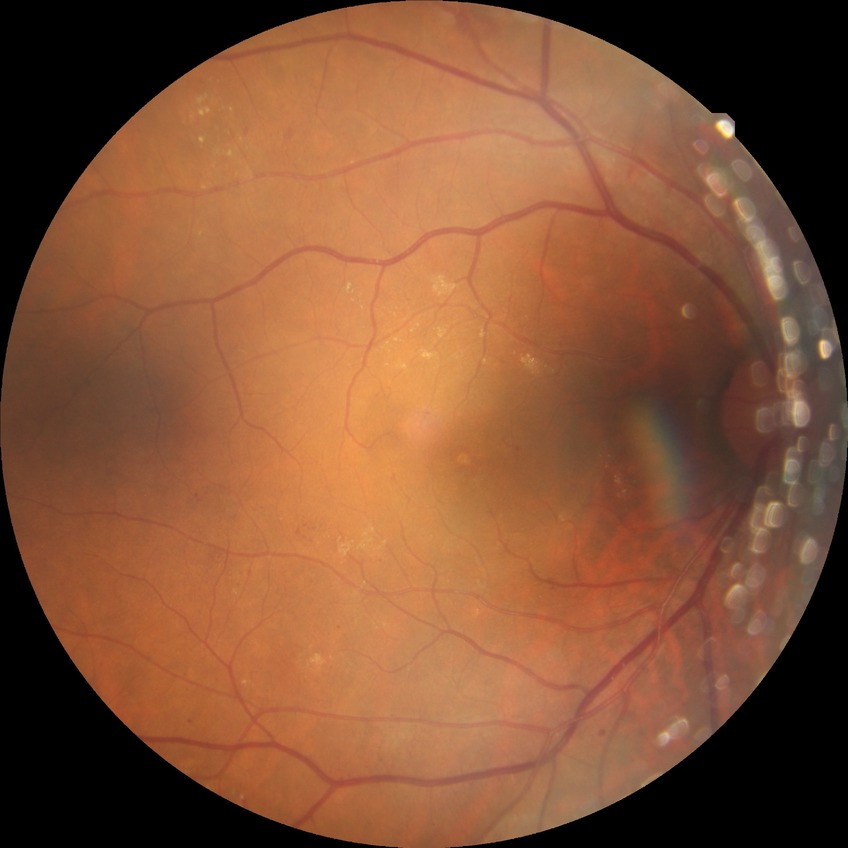
{"davis_grade": "simple diabetic retinopathy"}